Camera: Kowa VX-10α, mydriatic (tropicamide 0.5%), color fundus image:
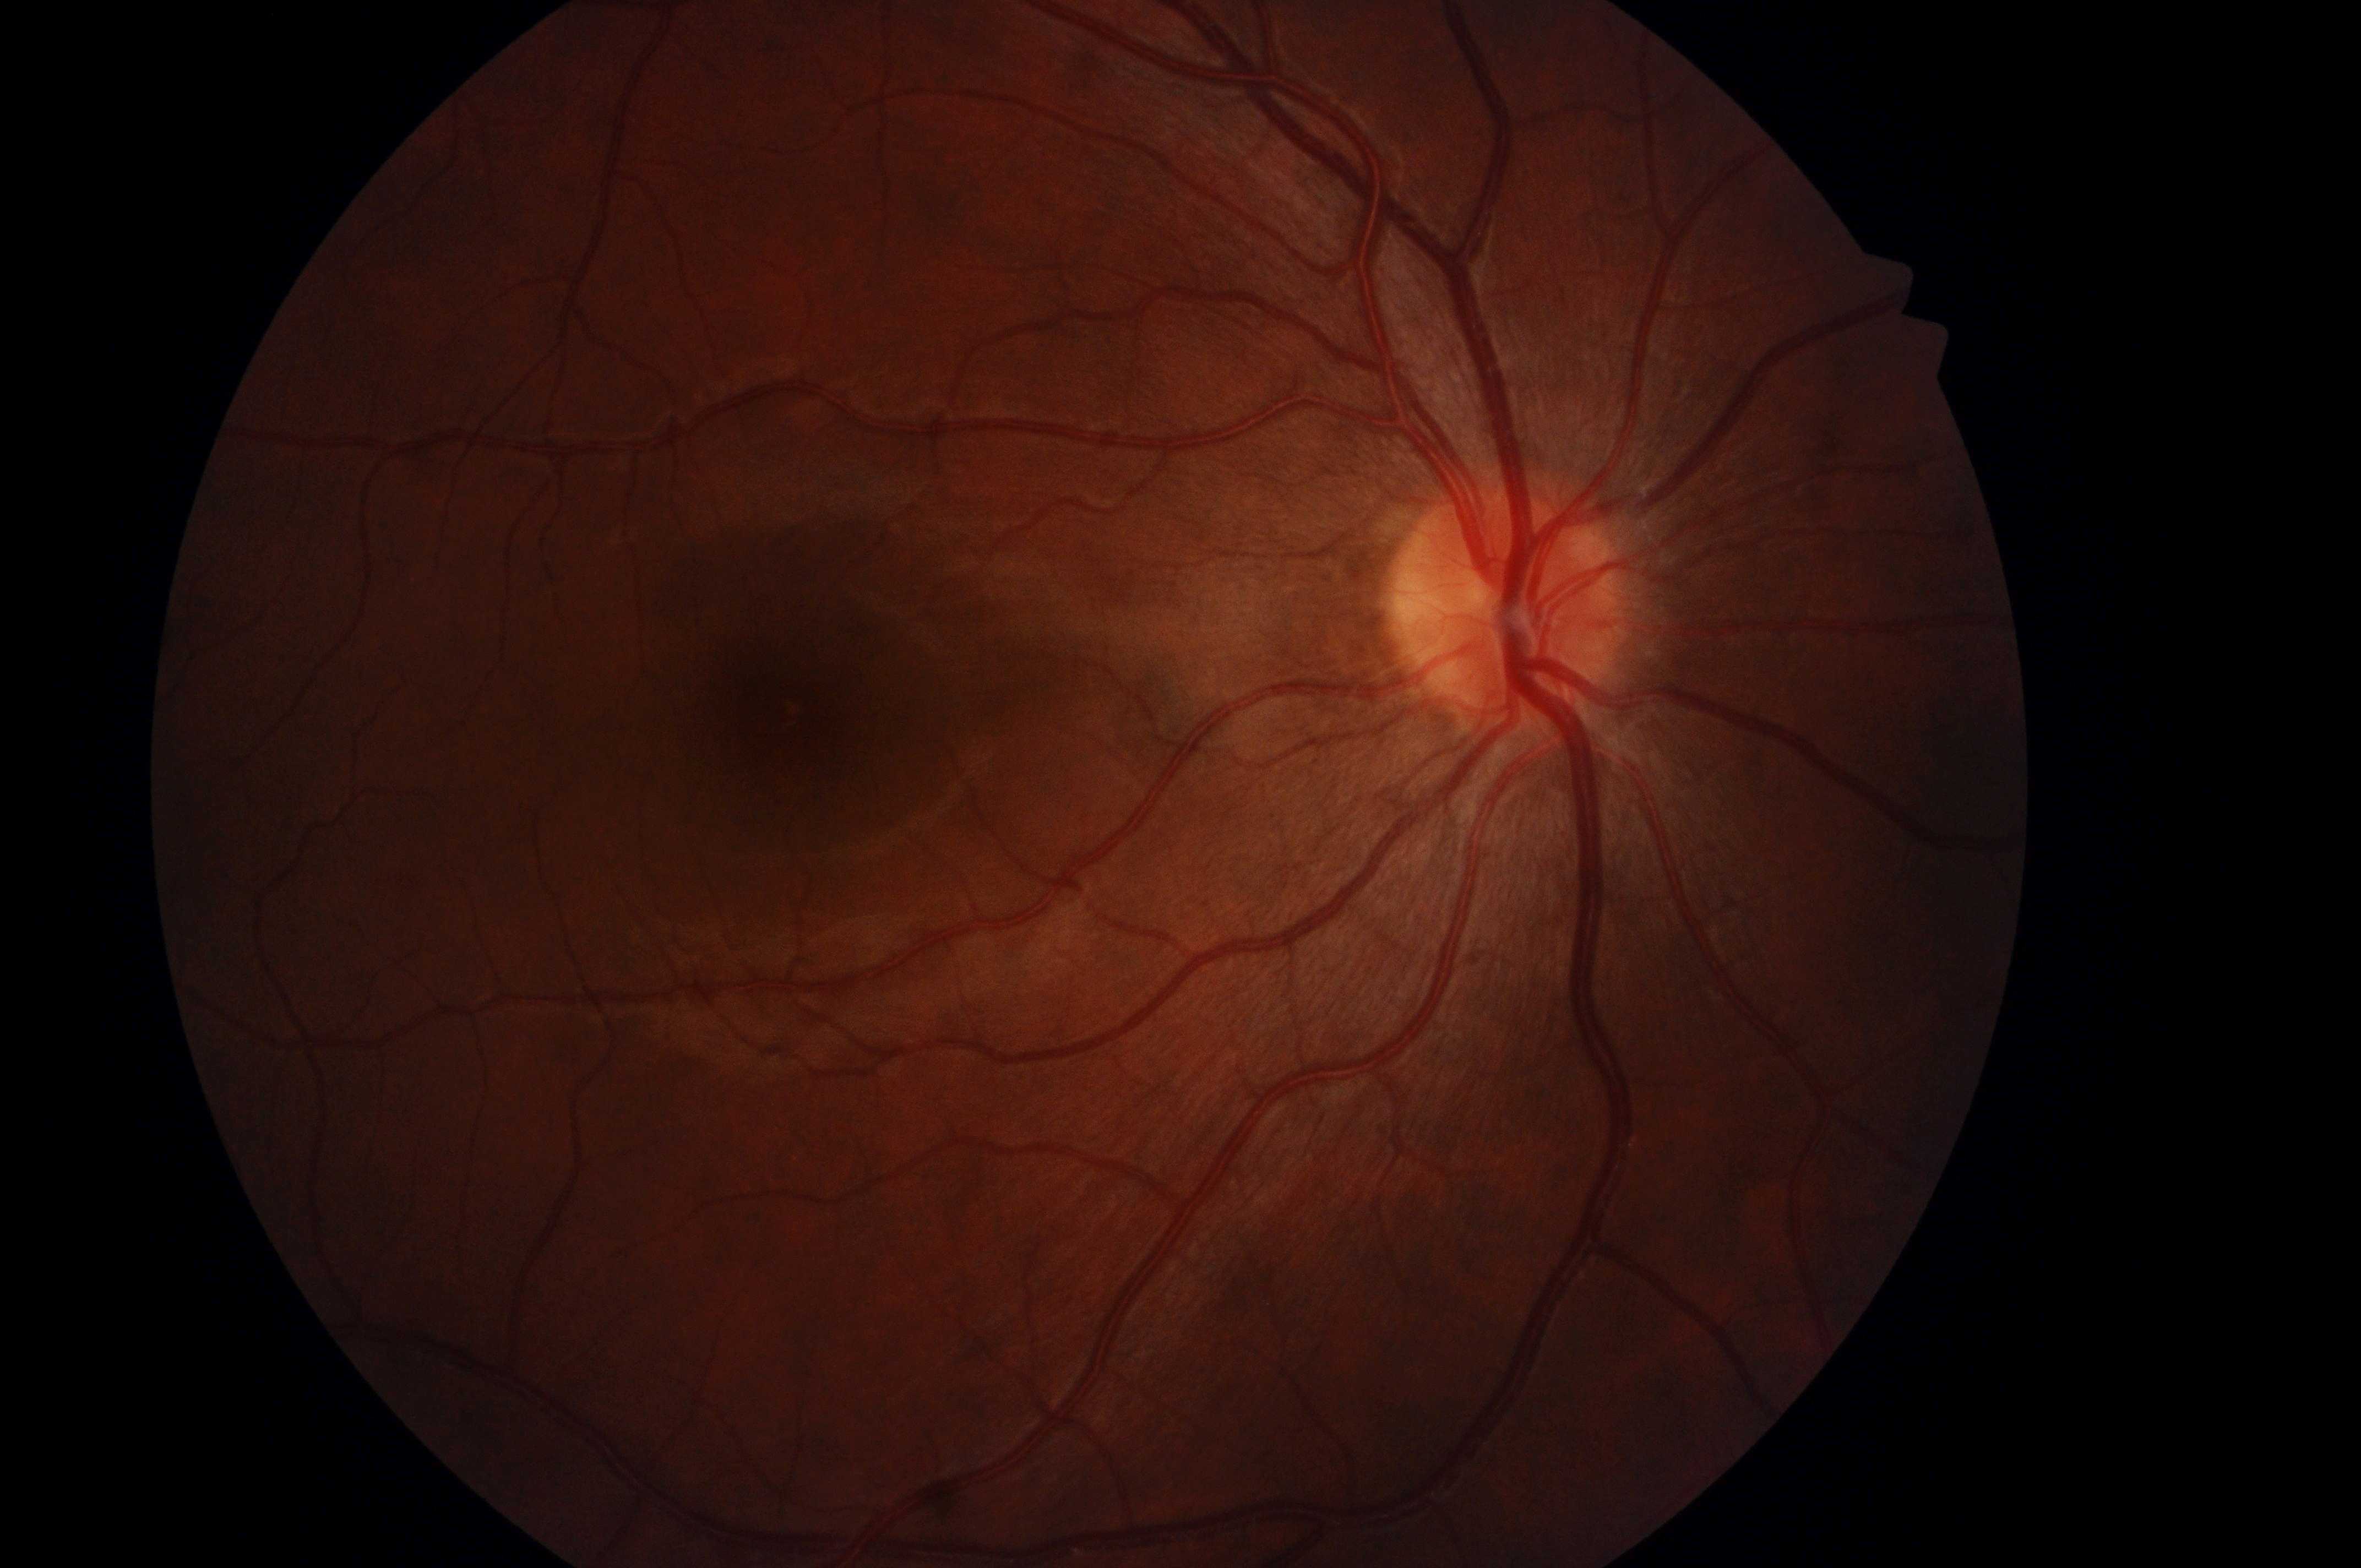
Q: DR stage?
A: 0/4
Q: Macular edema risk?
A: 0/2
Q: Right or left eye?
A: right eye
Q: Optic disc center?
A: (x: 1502, y: 614)
Q: Where is the fovea?
A: (x: 775, y: 715)